1659 by 2212 pixels: 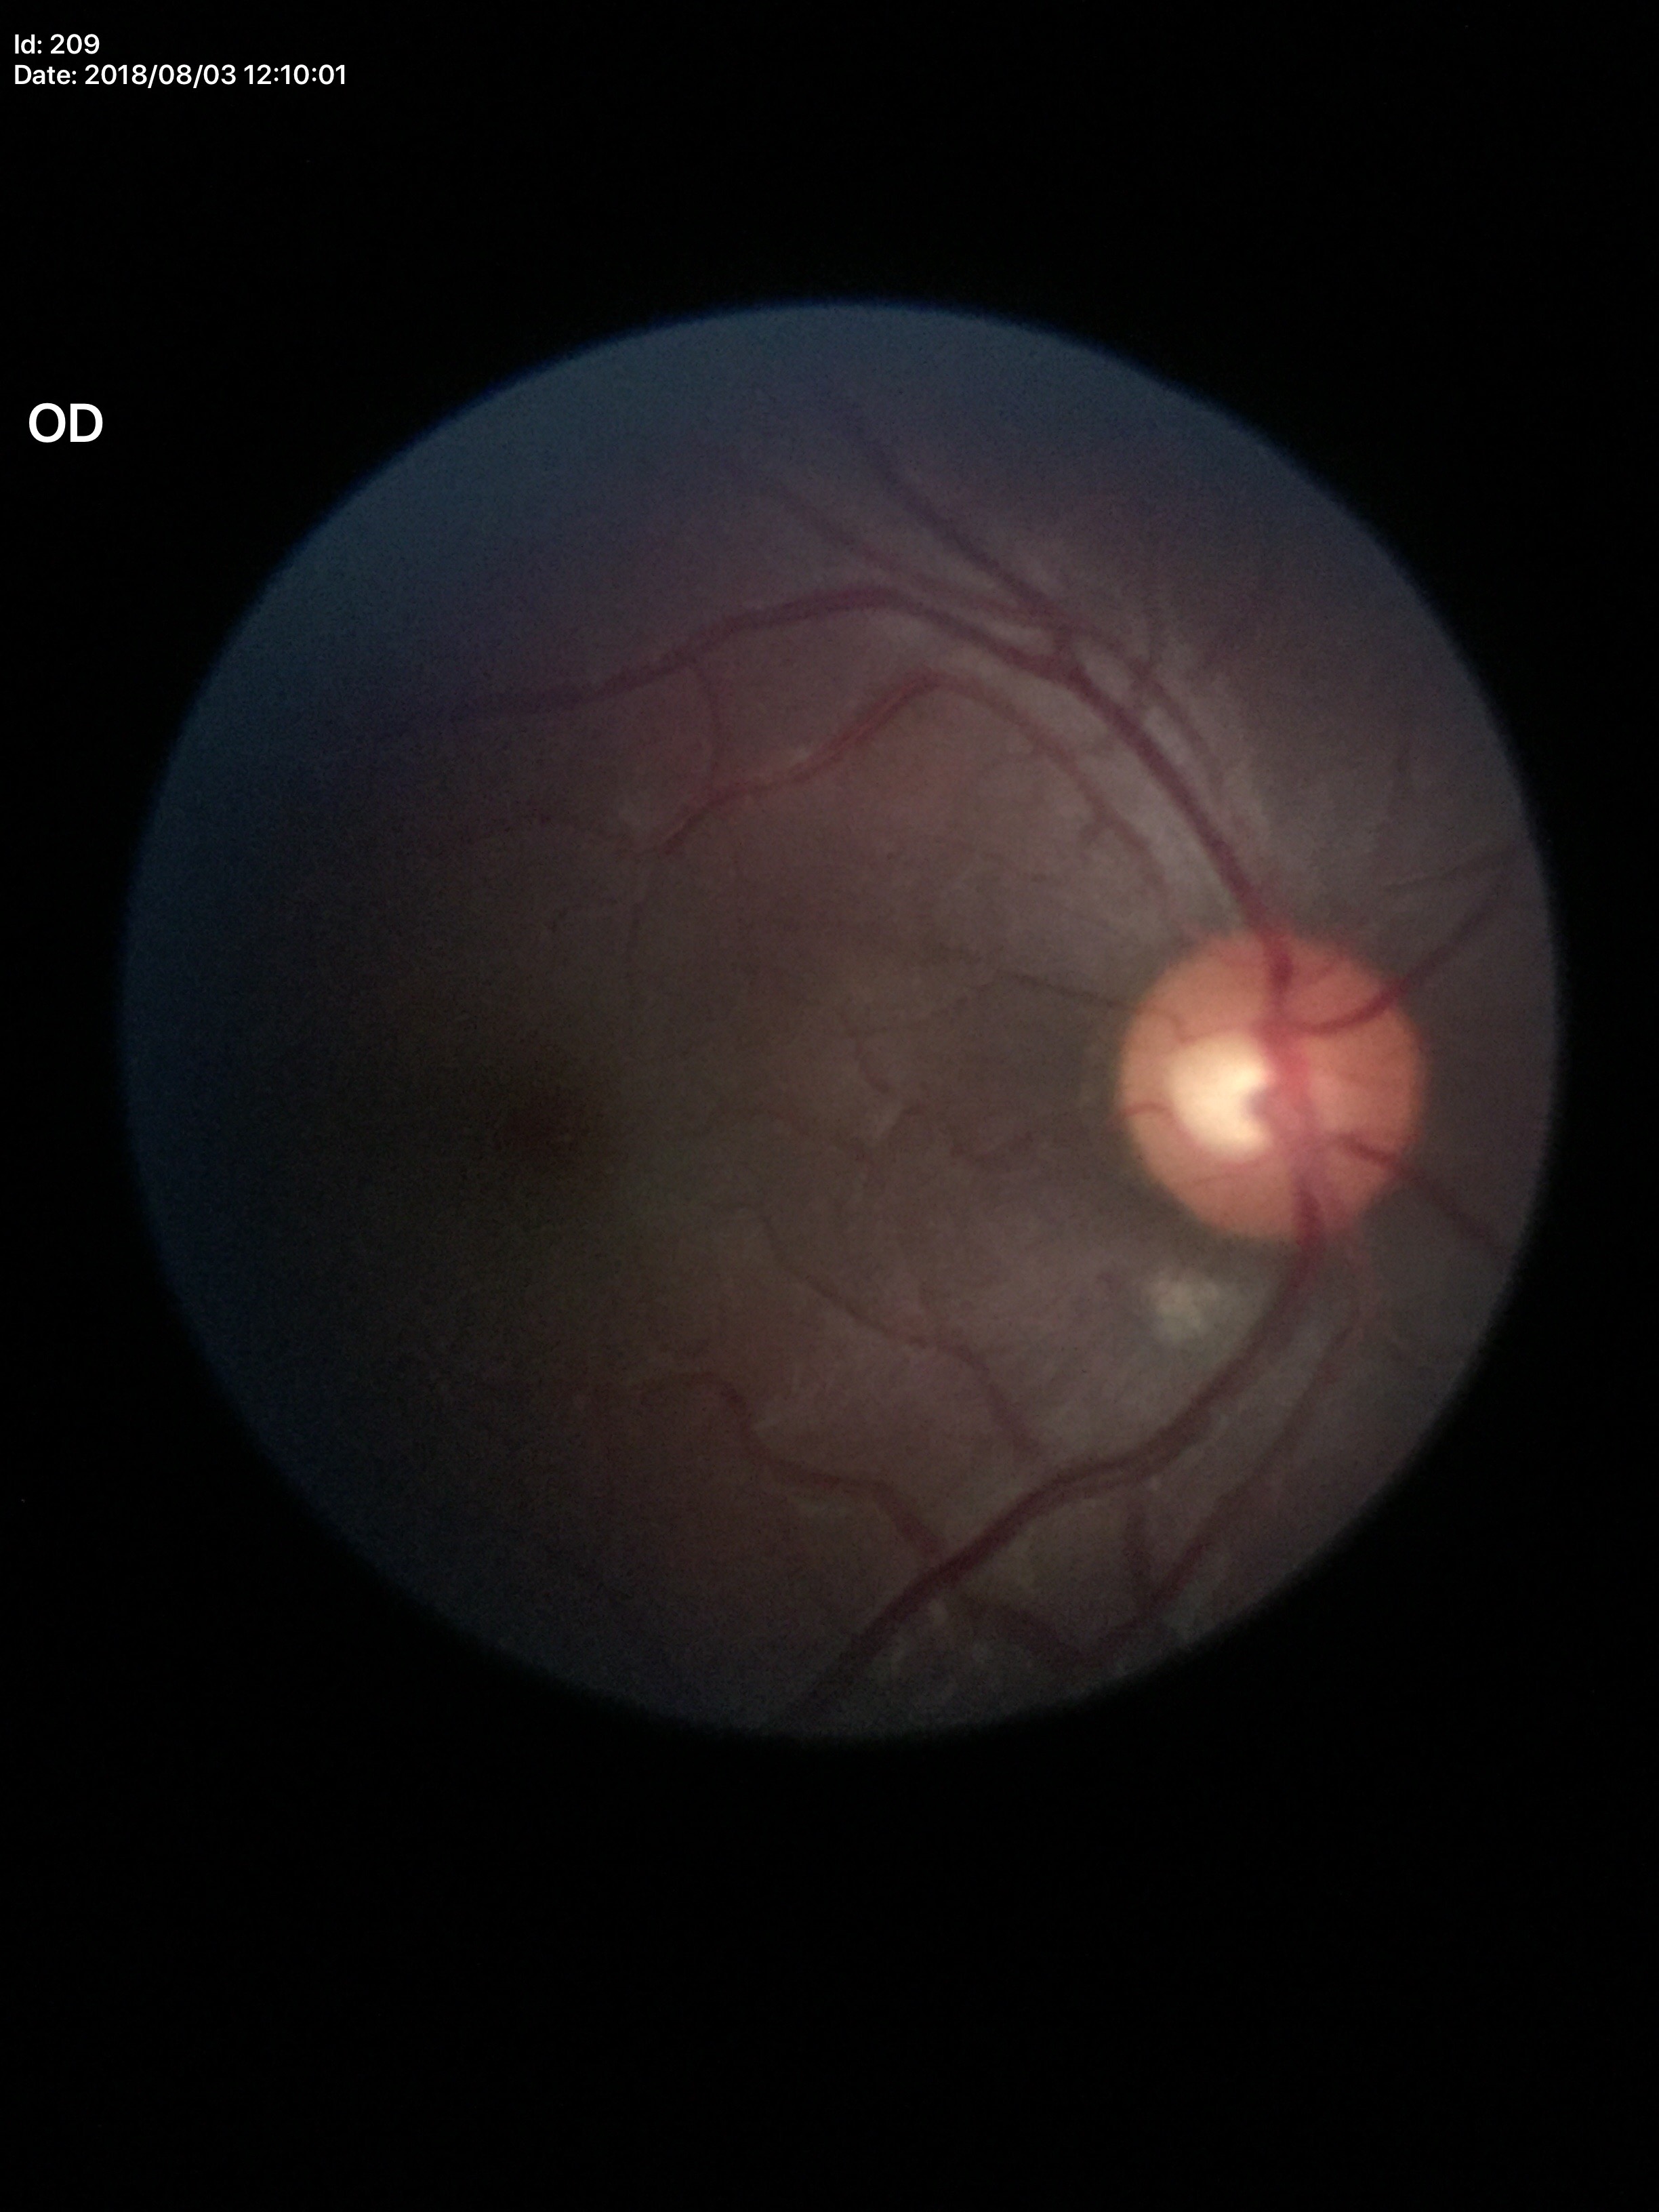 Negative for glaucoma suspicion.
VCDR of 0.50.
HCDR is 0.58.